Image size 2352x1568
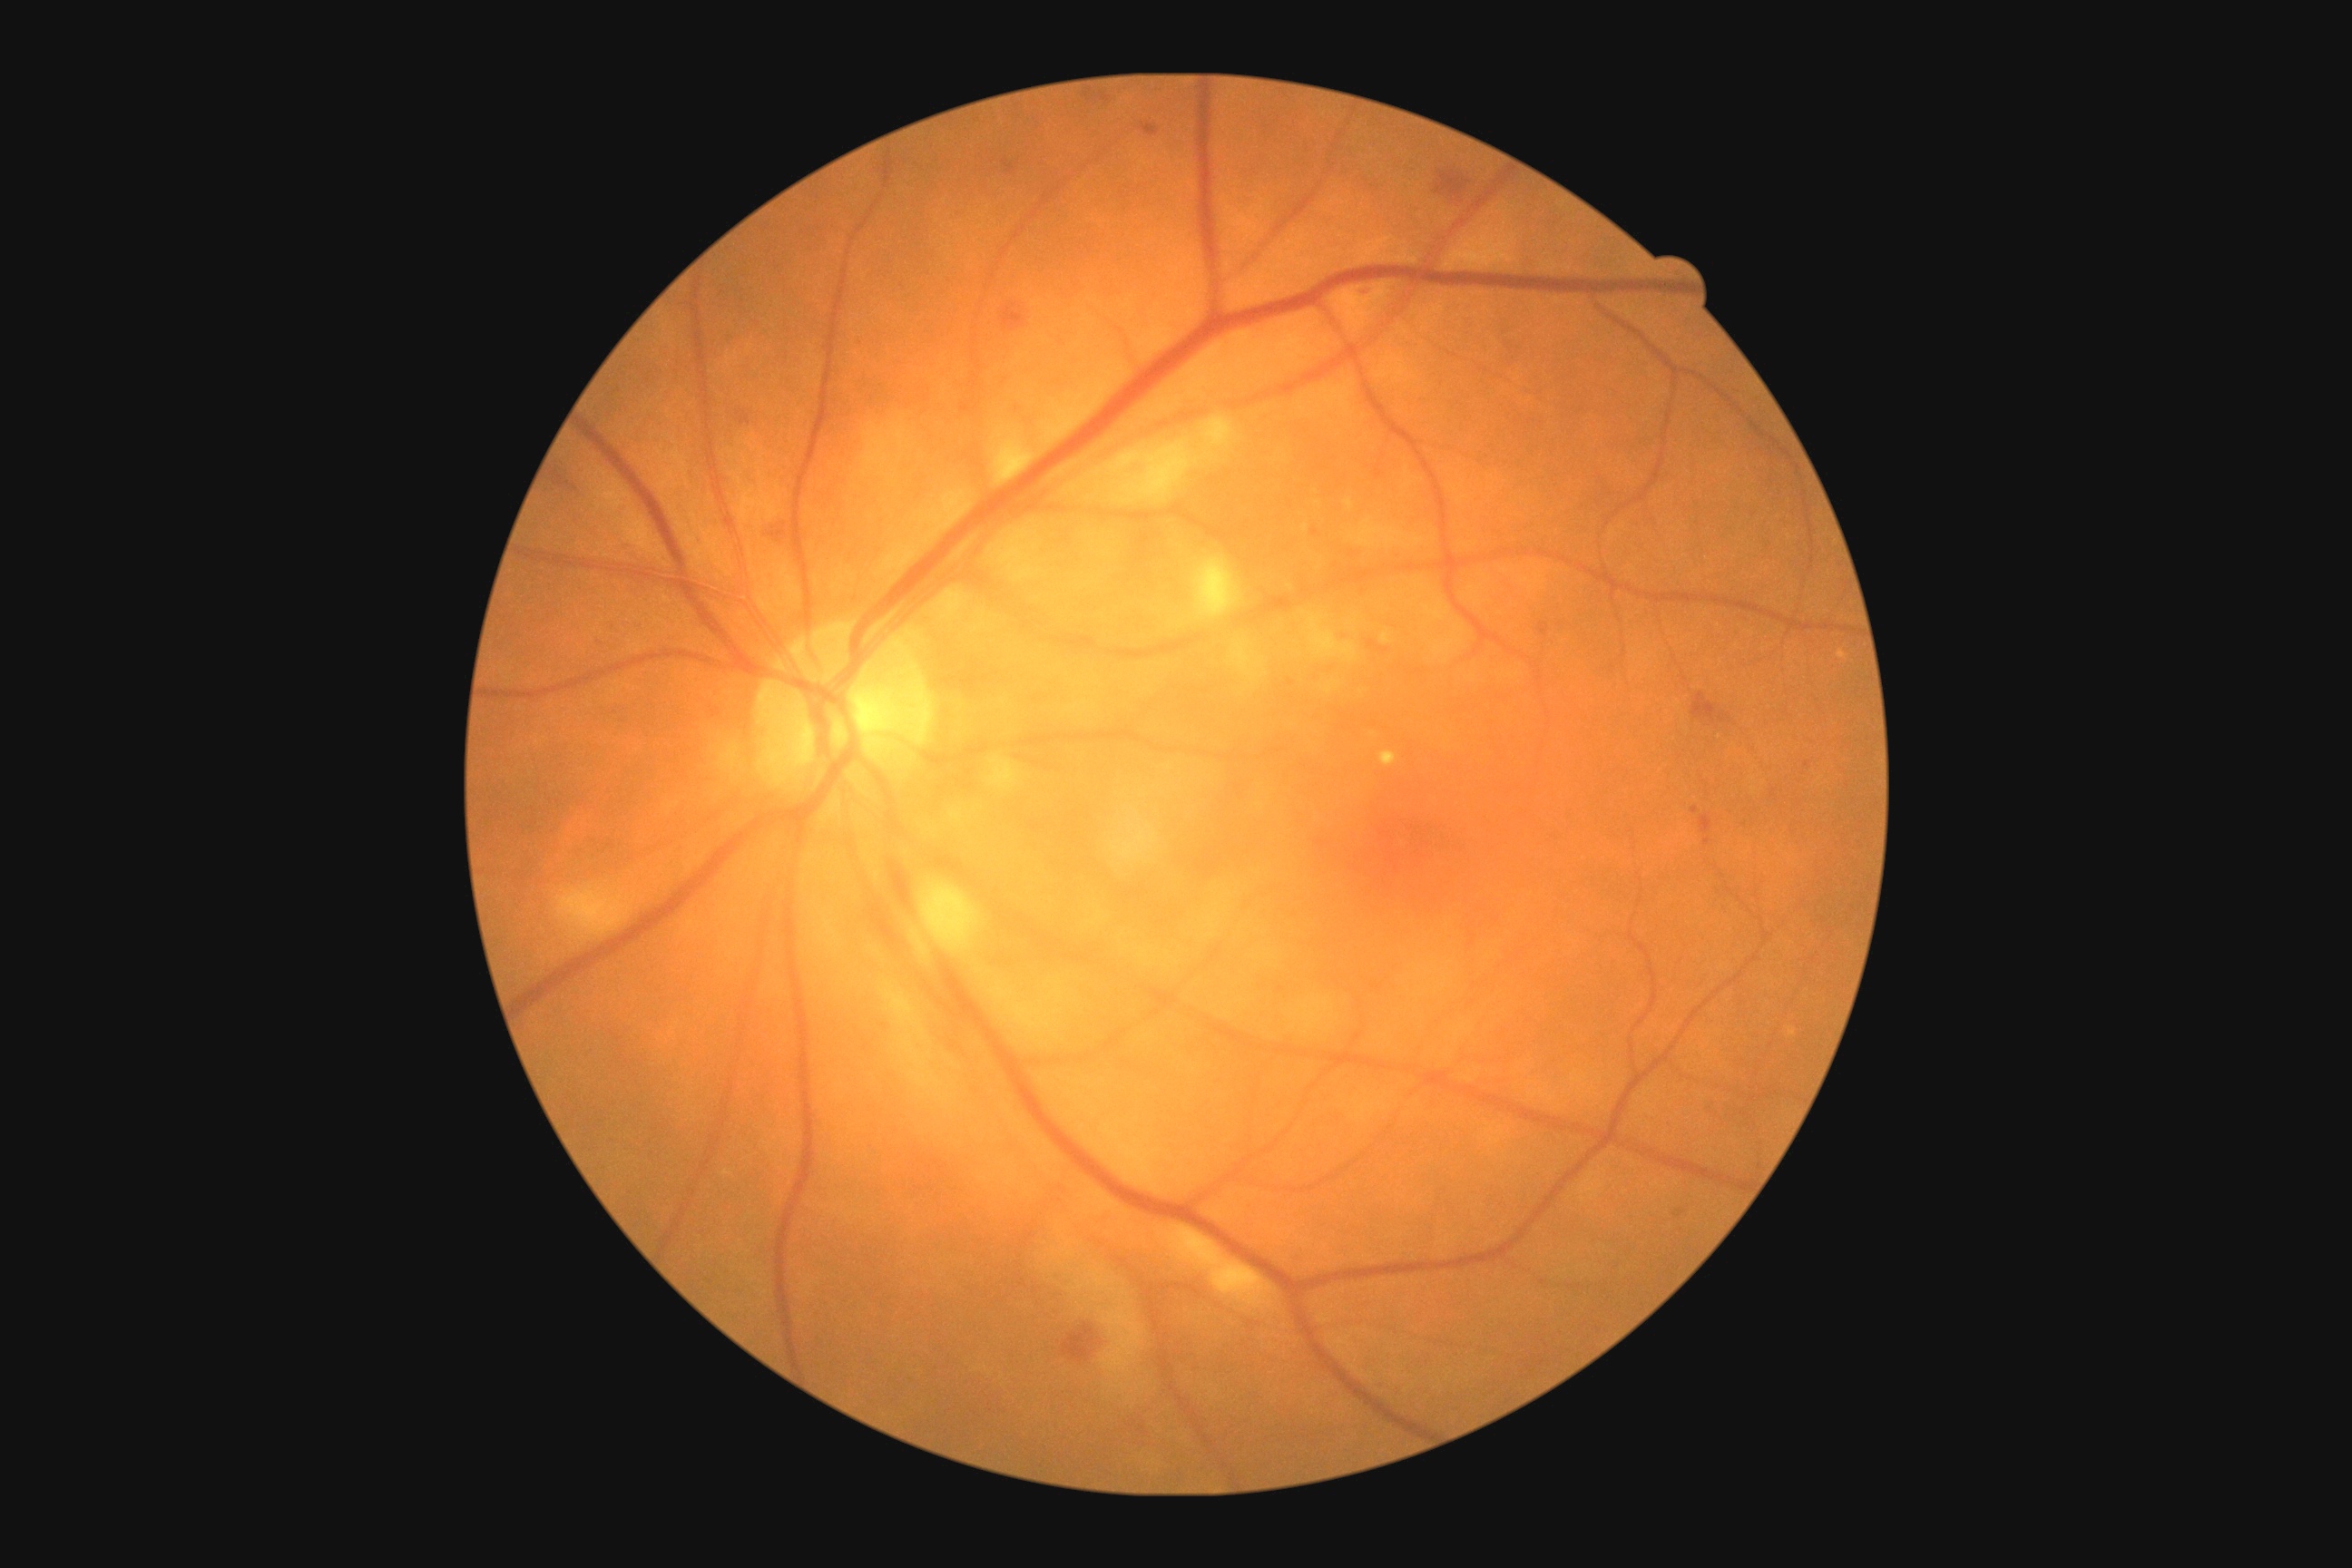 DR is 2.